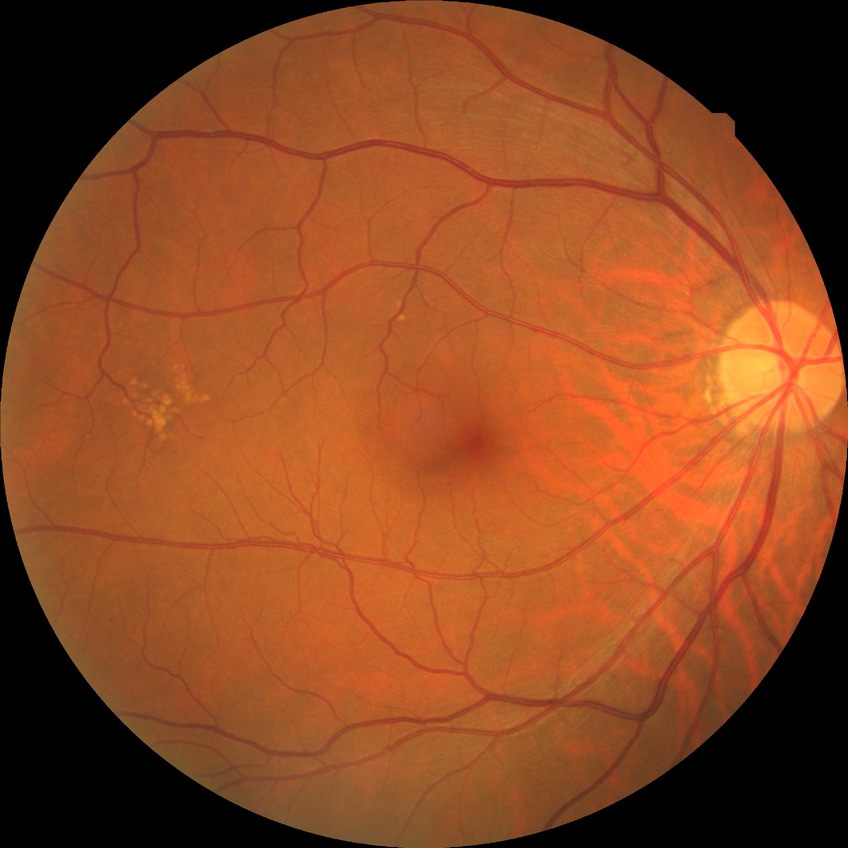

diabetic retinopathy (DR)@no diabetic retinopathy (NDR).